Acquired on the Phoenix ICON · image size 1240x1240 · wide-field fundus photograph of an infant: 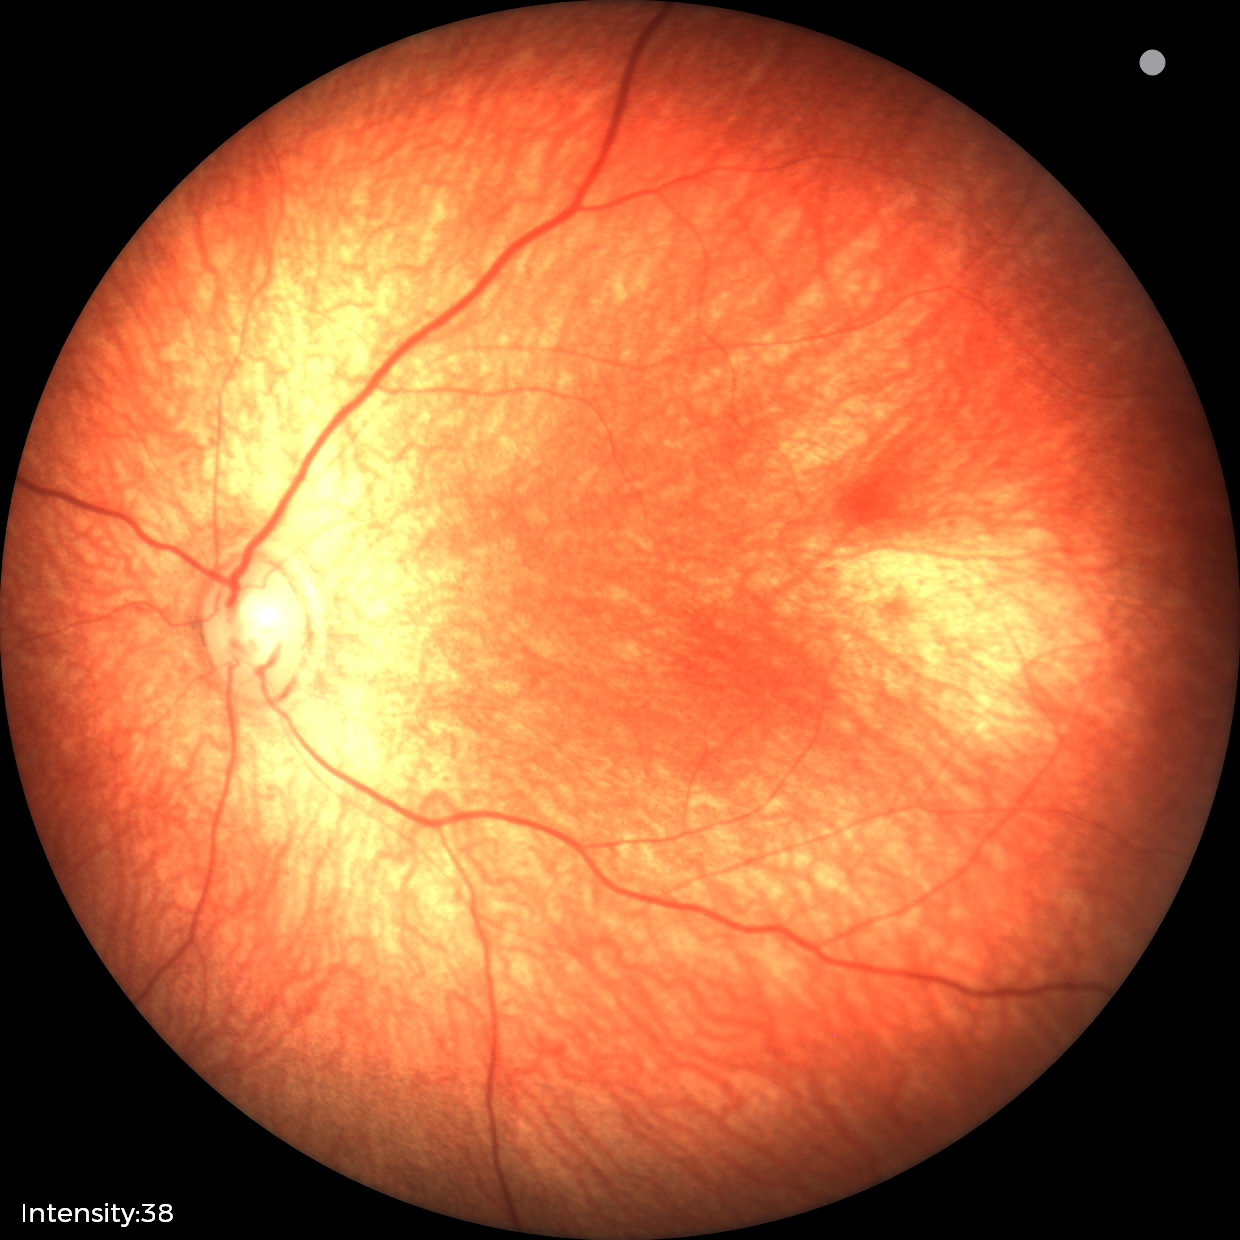
Finding: normal.